45-degree field of view · 2352 by 1568 pixels:
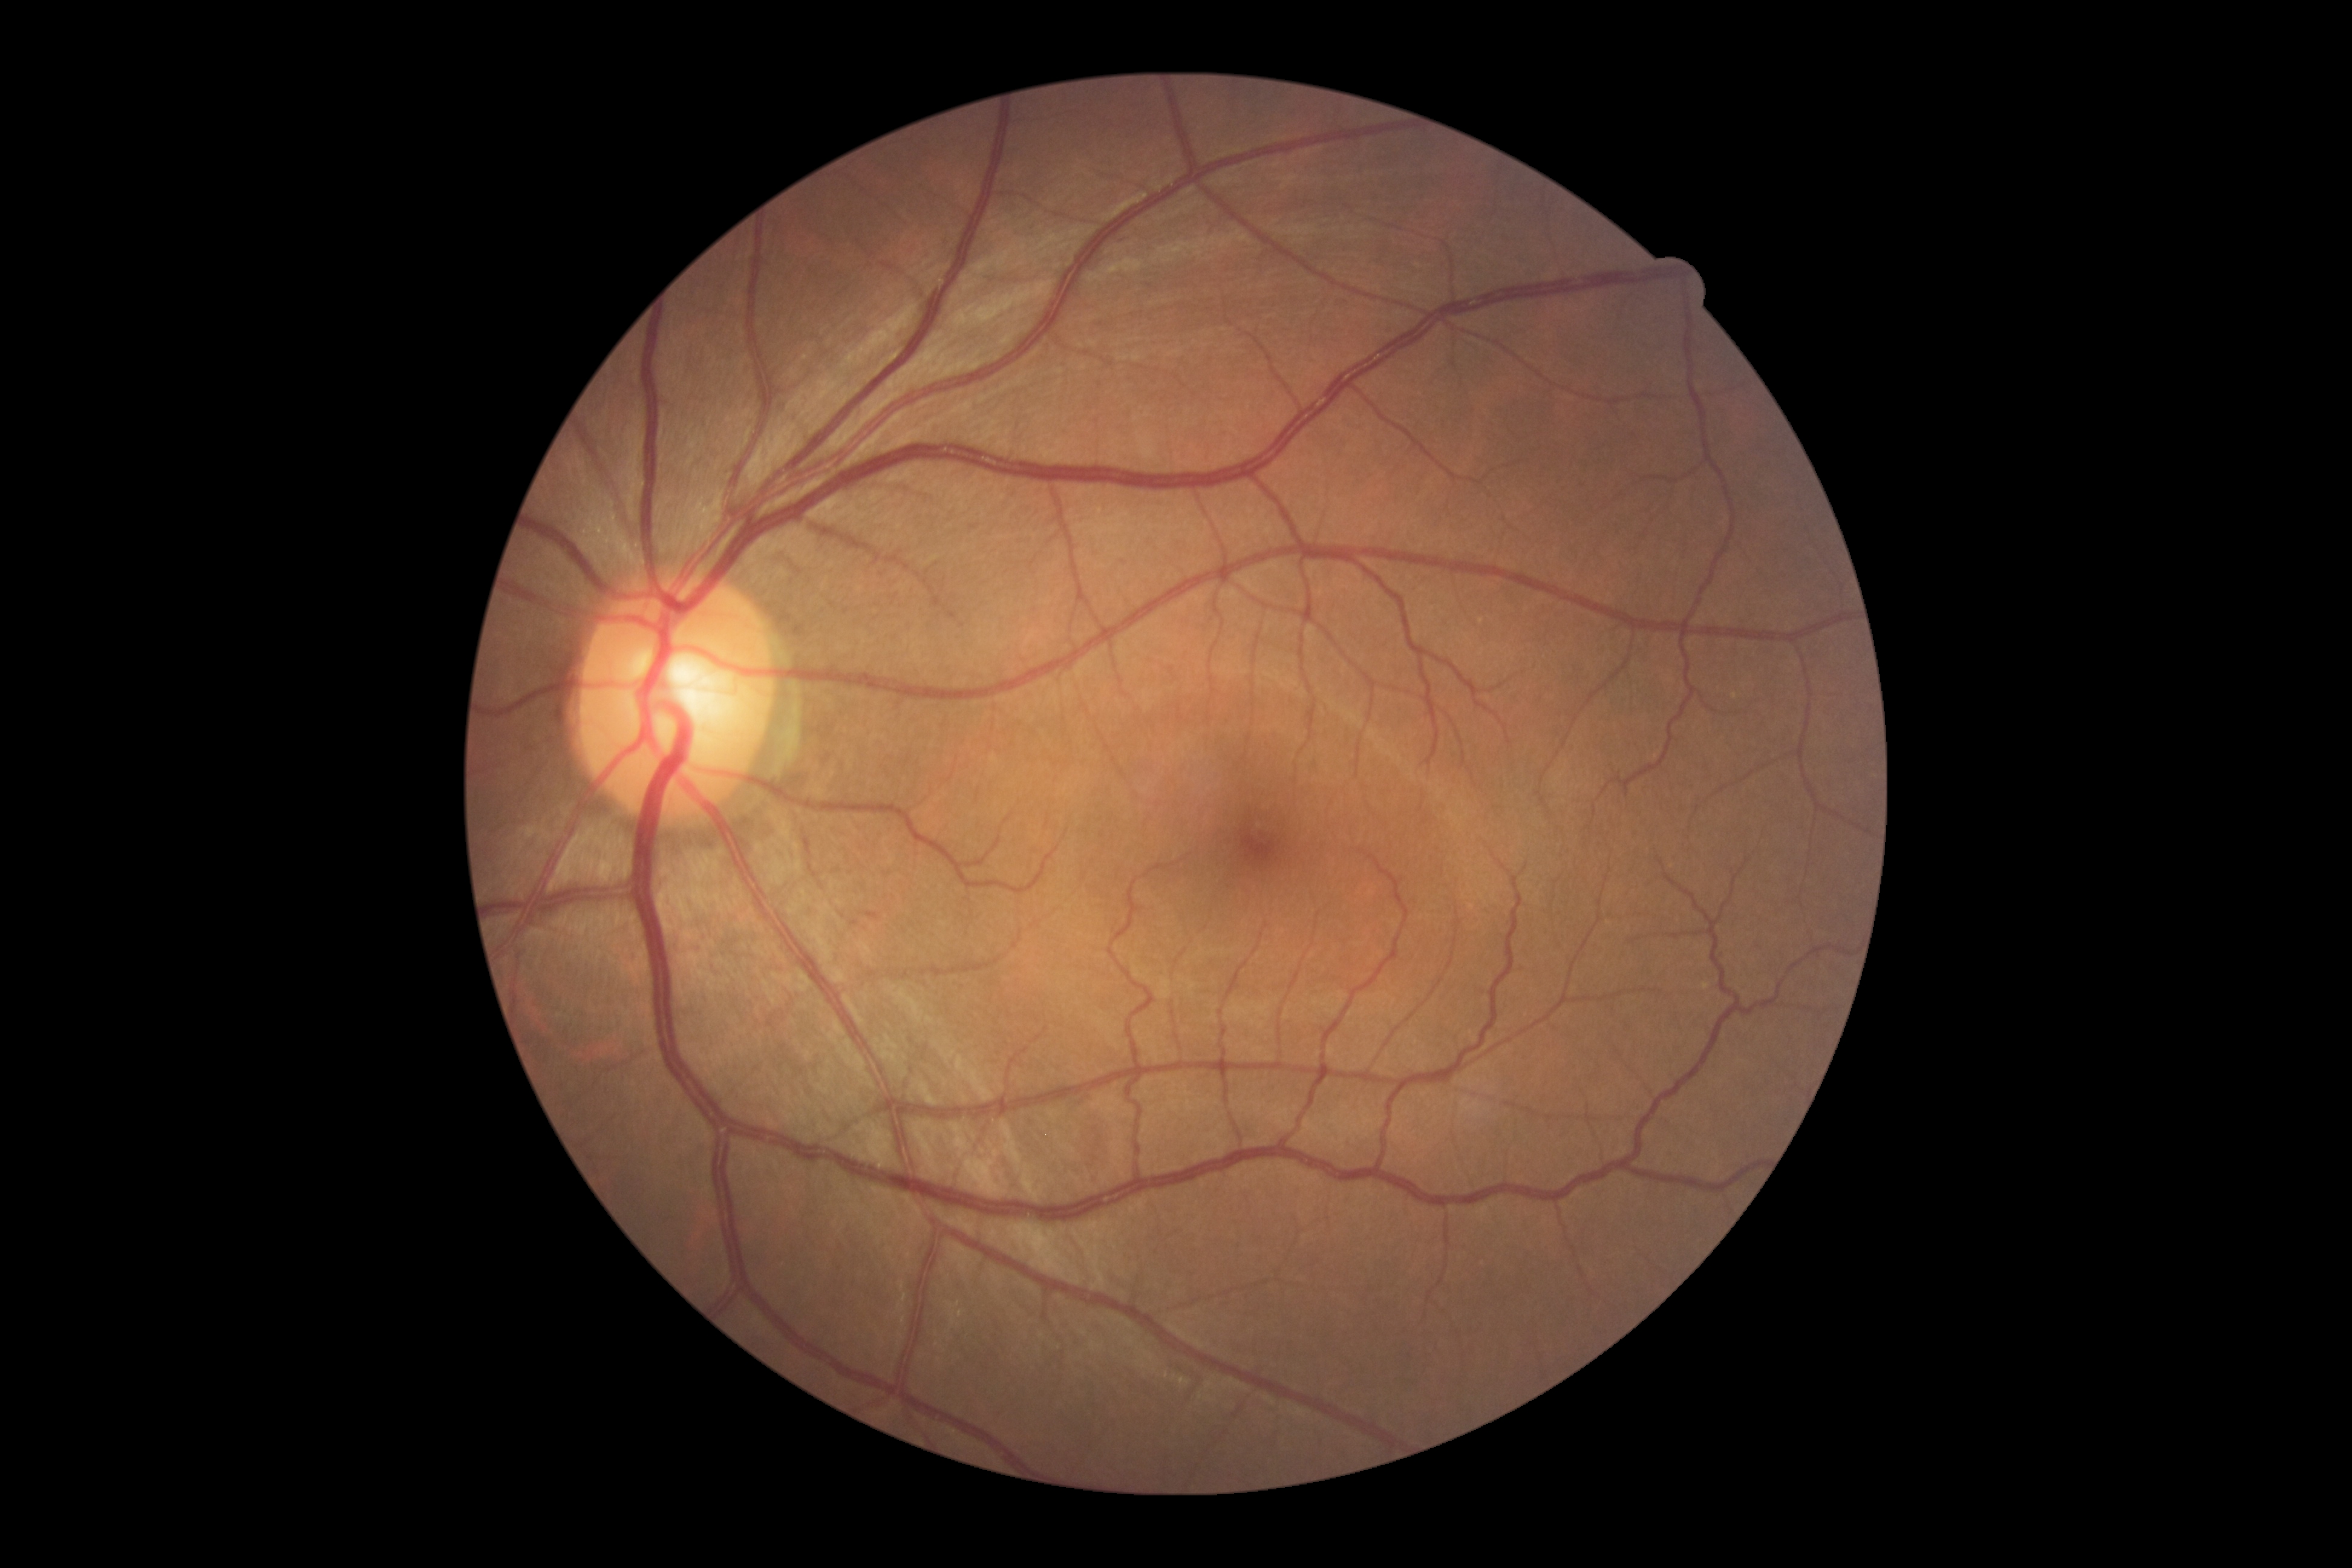

No diabetic retinal disease findings. Diabetic retinopathy is grade 0.